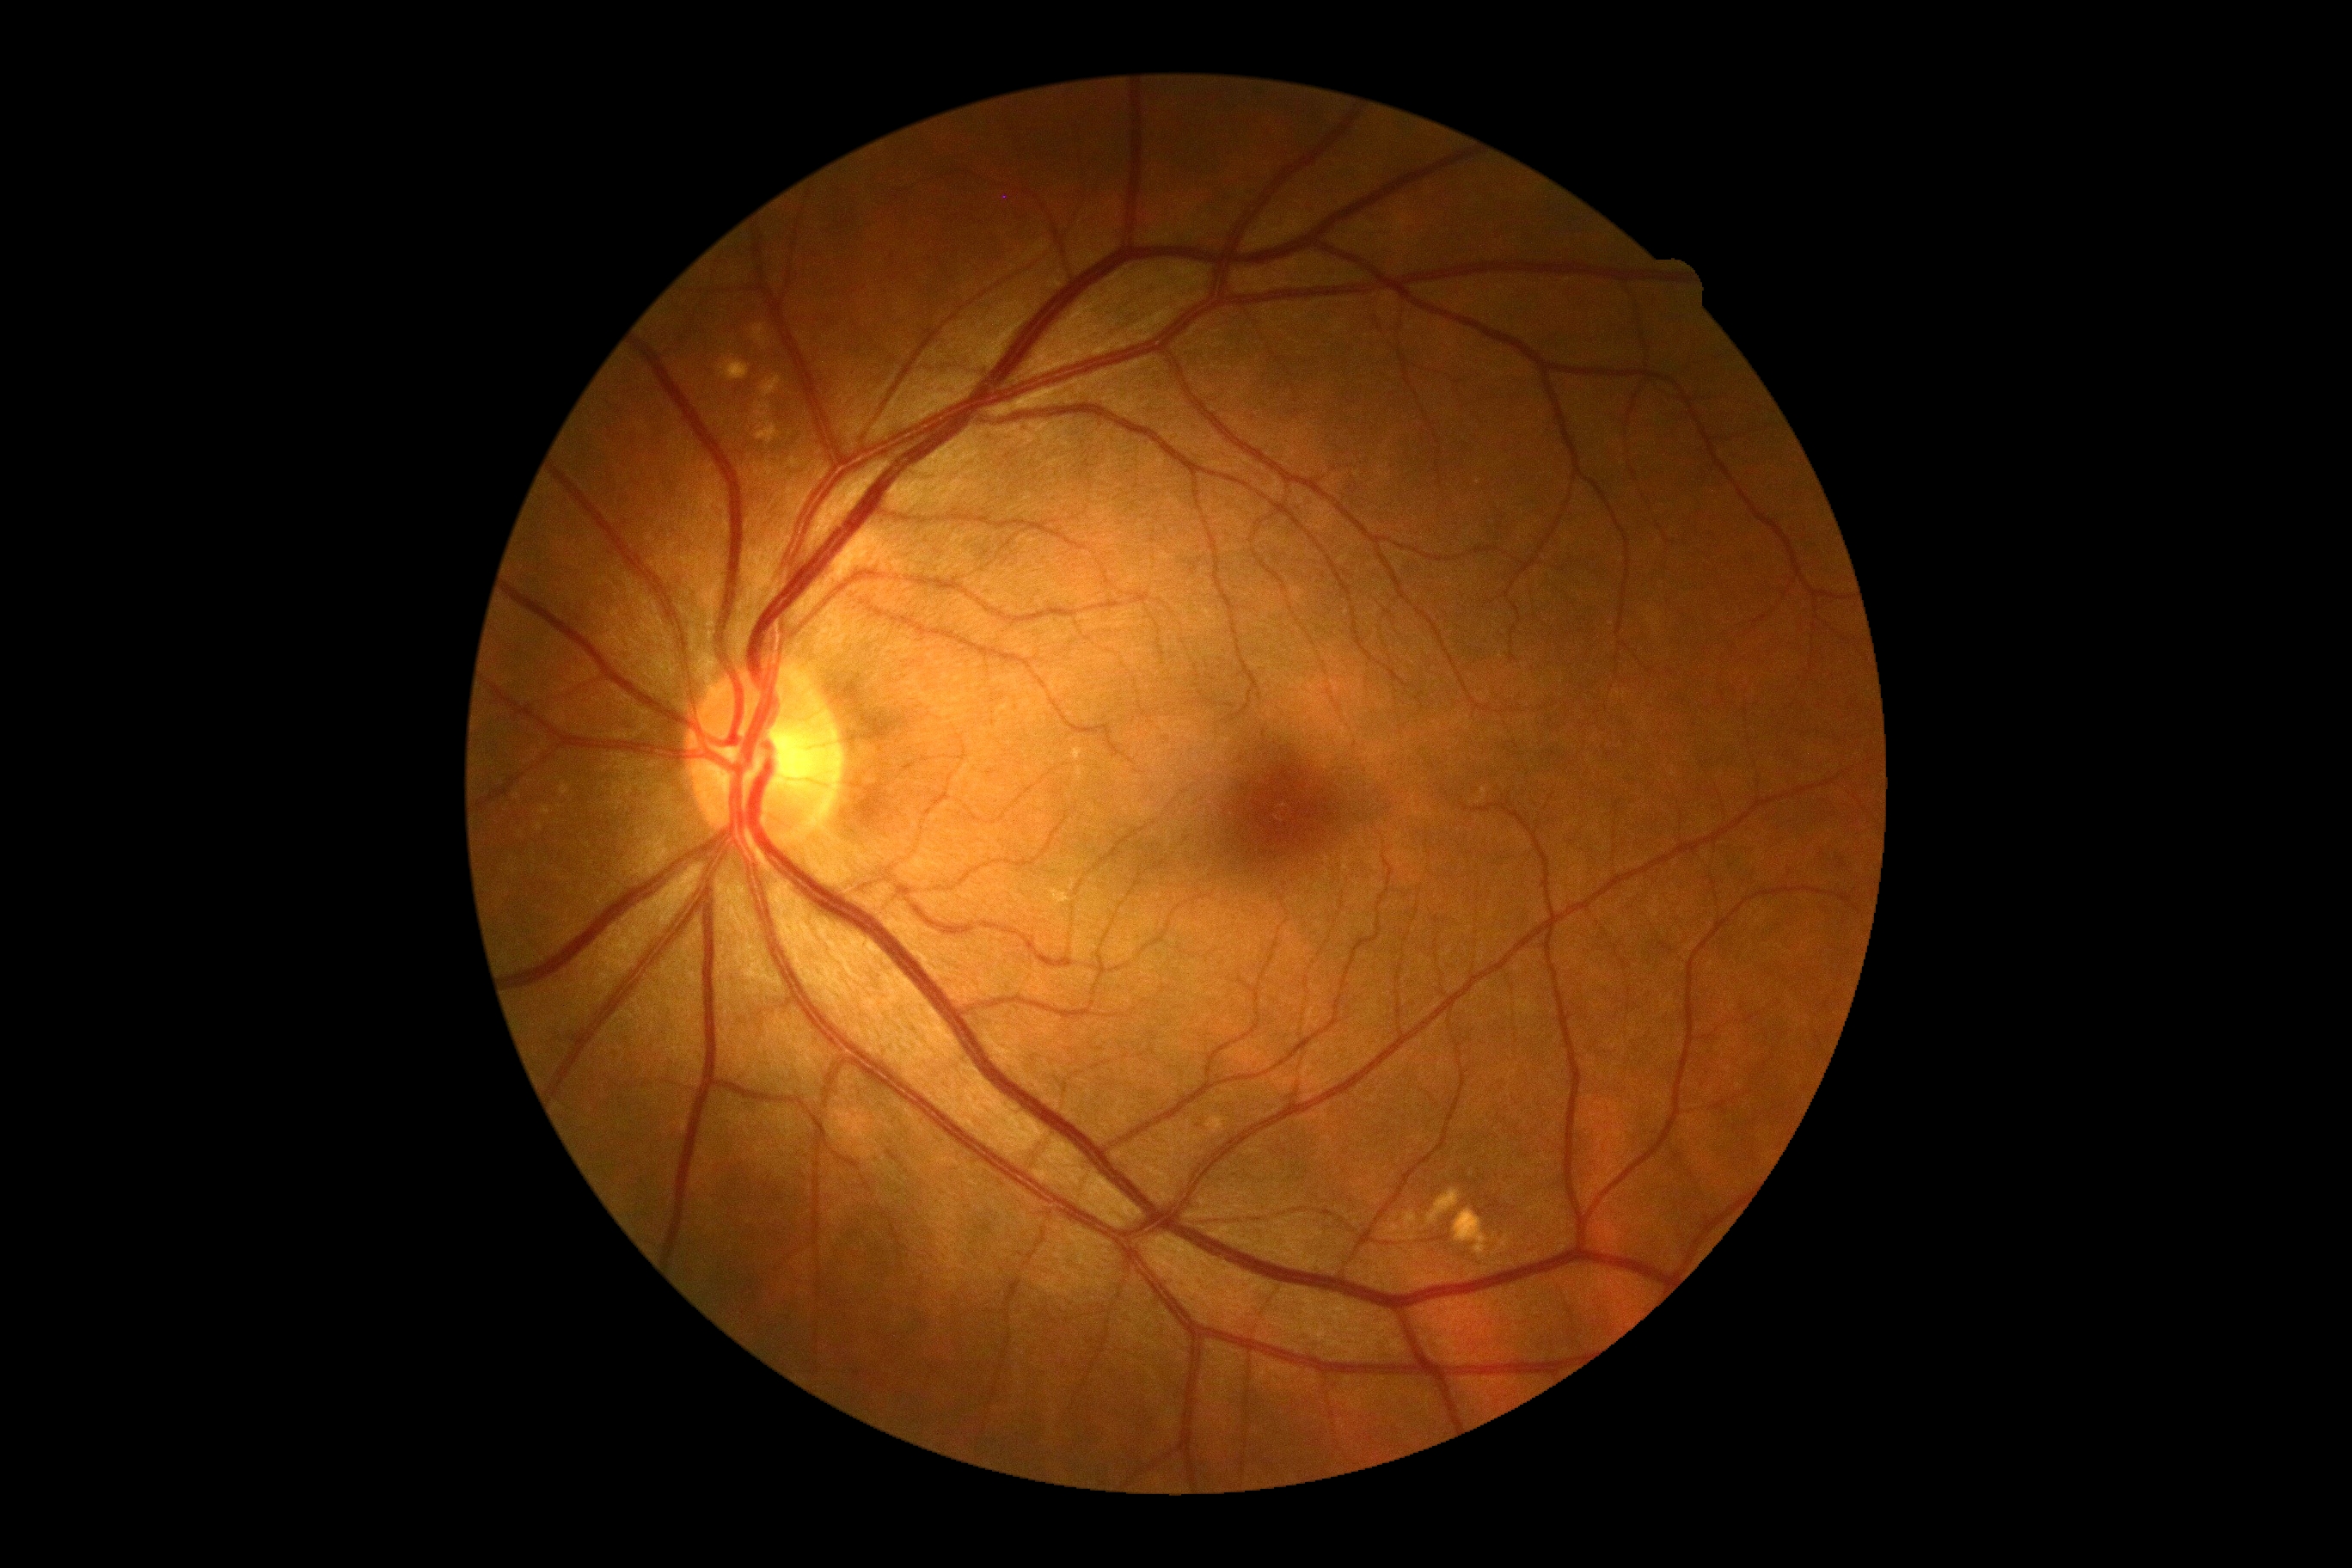

Diabetic retinopathy is no apparent diabetic retinopathy (grade 0).